CFP: 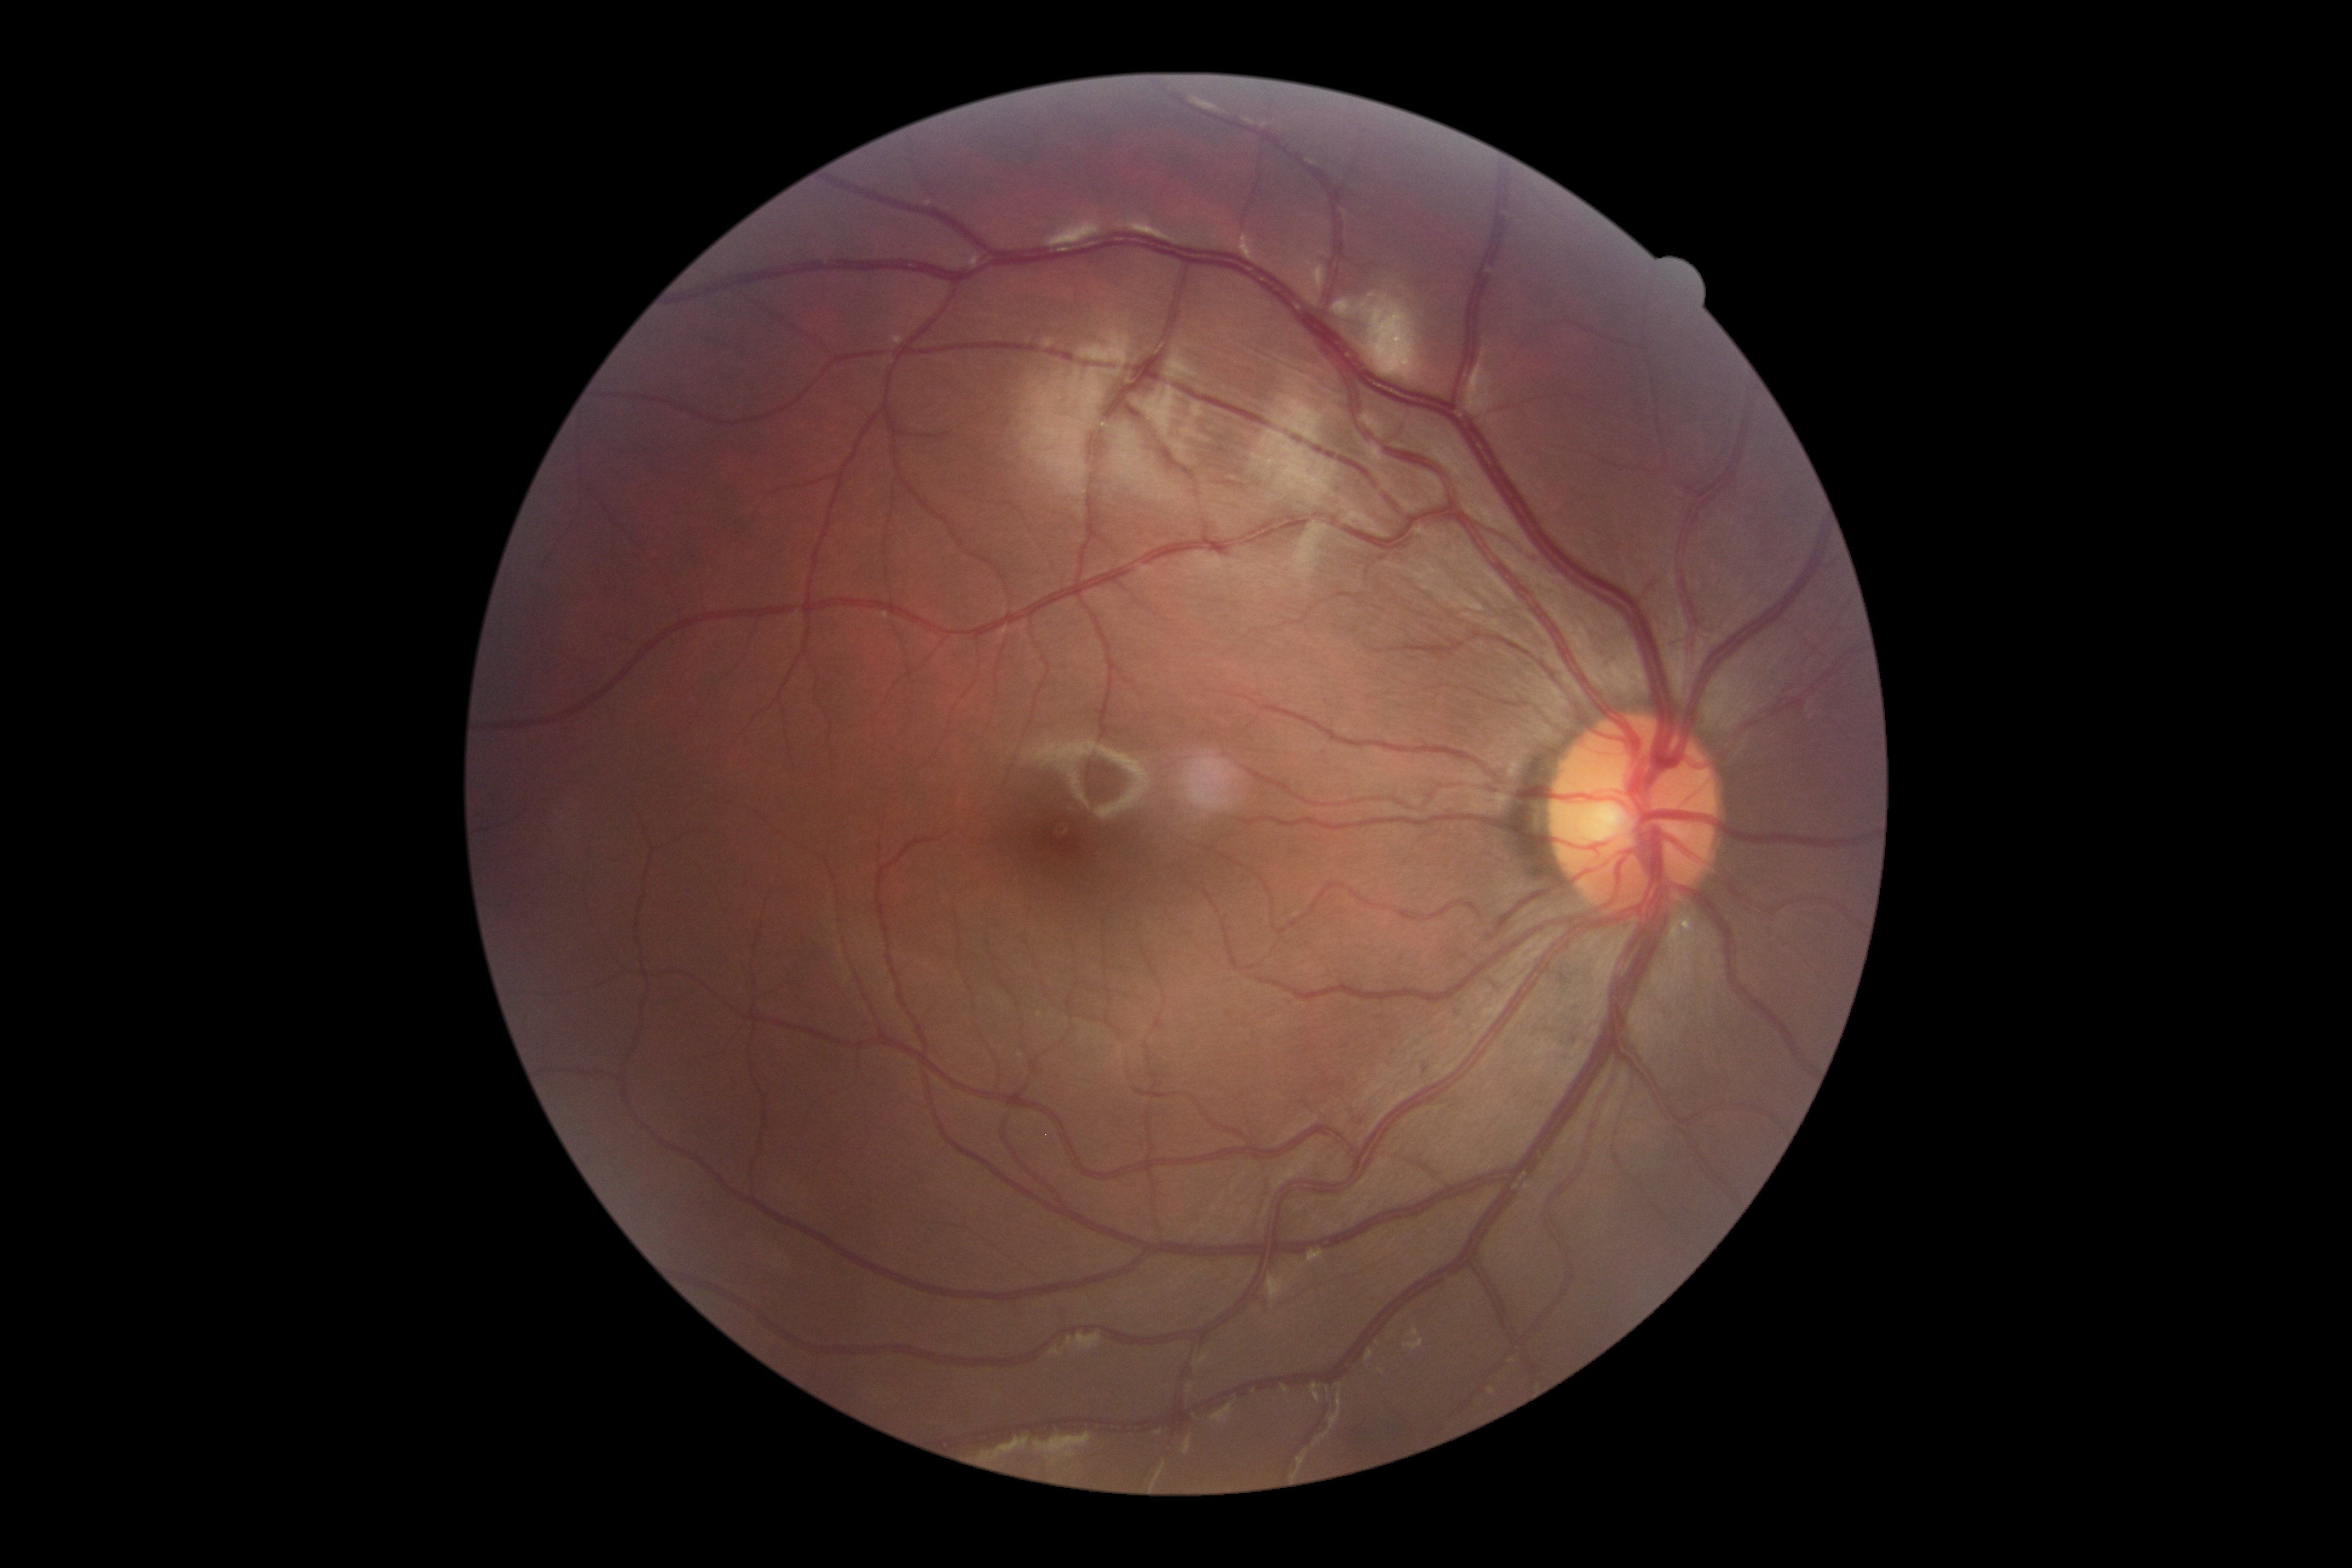 Diabetic retinopathy (DR): 0 — no visible signs of diabetic retinopathy. No signs of diabetic retinopathy.